2212 x 1659 pixels:
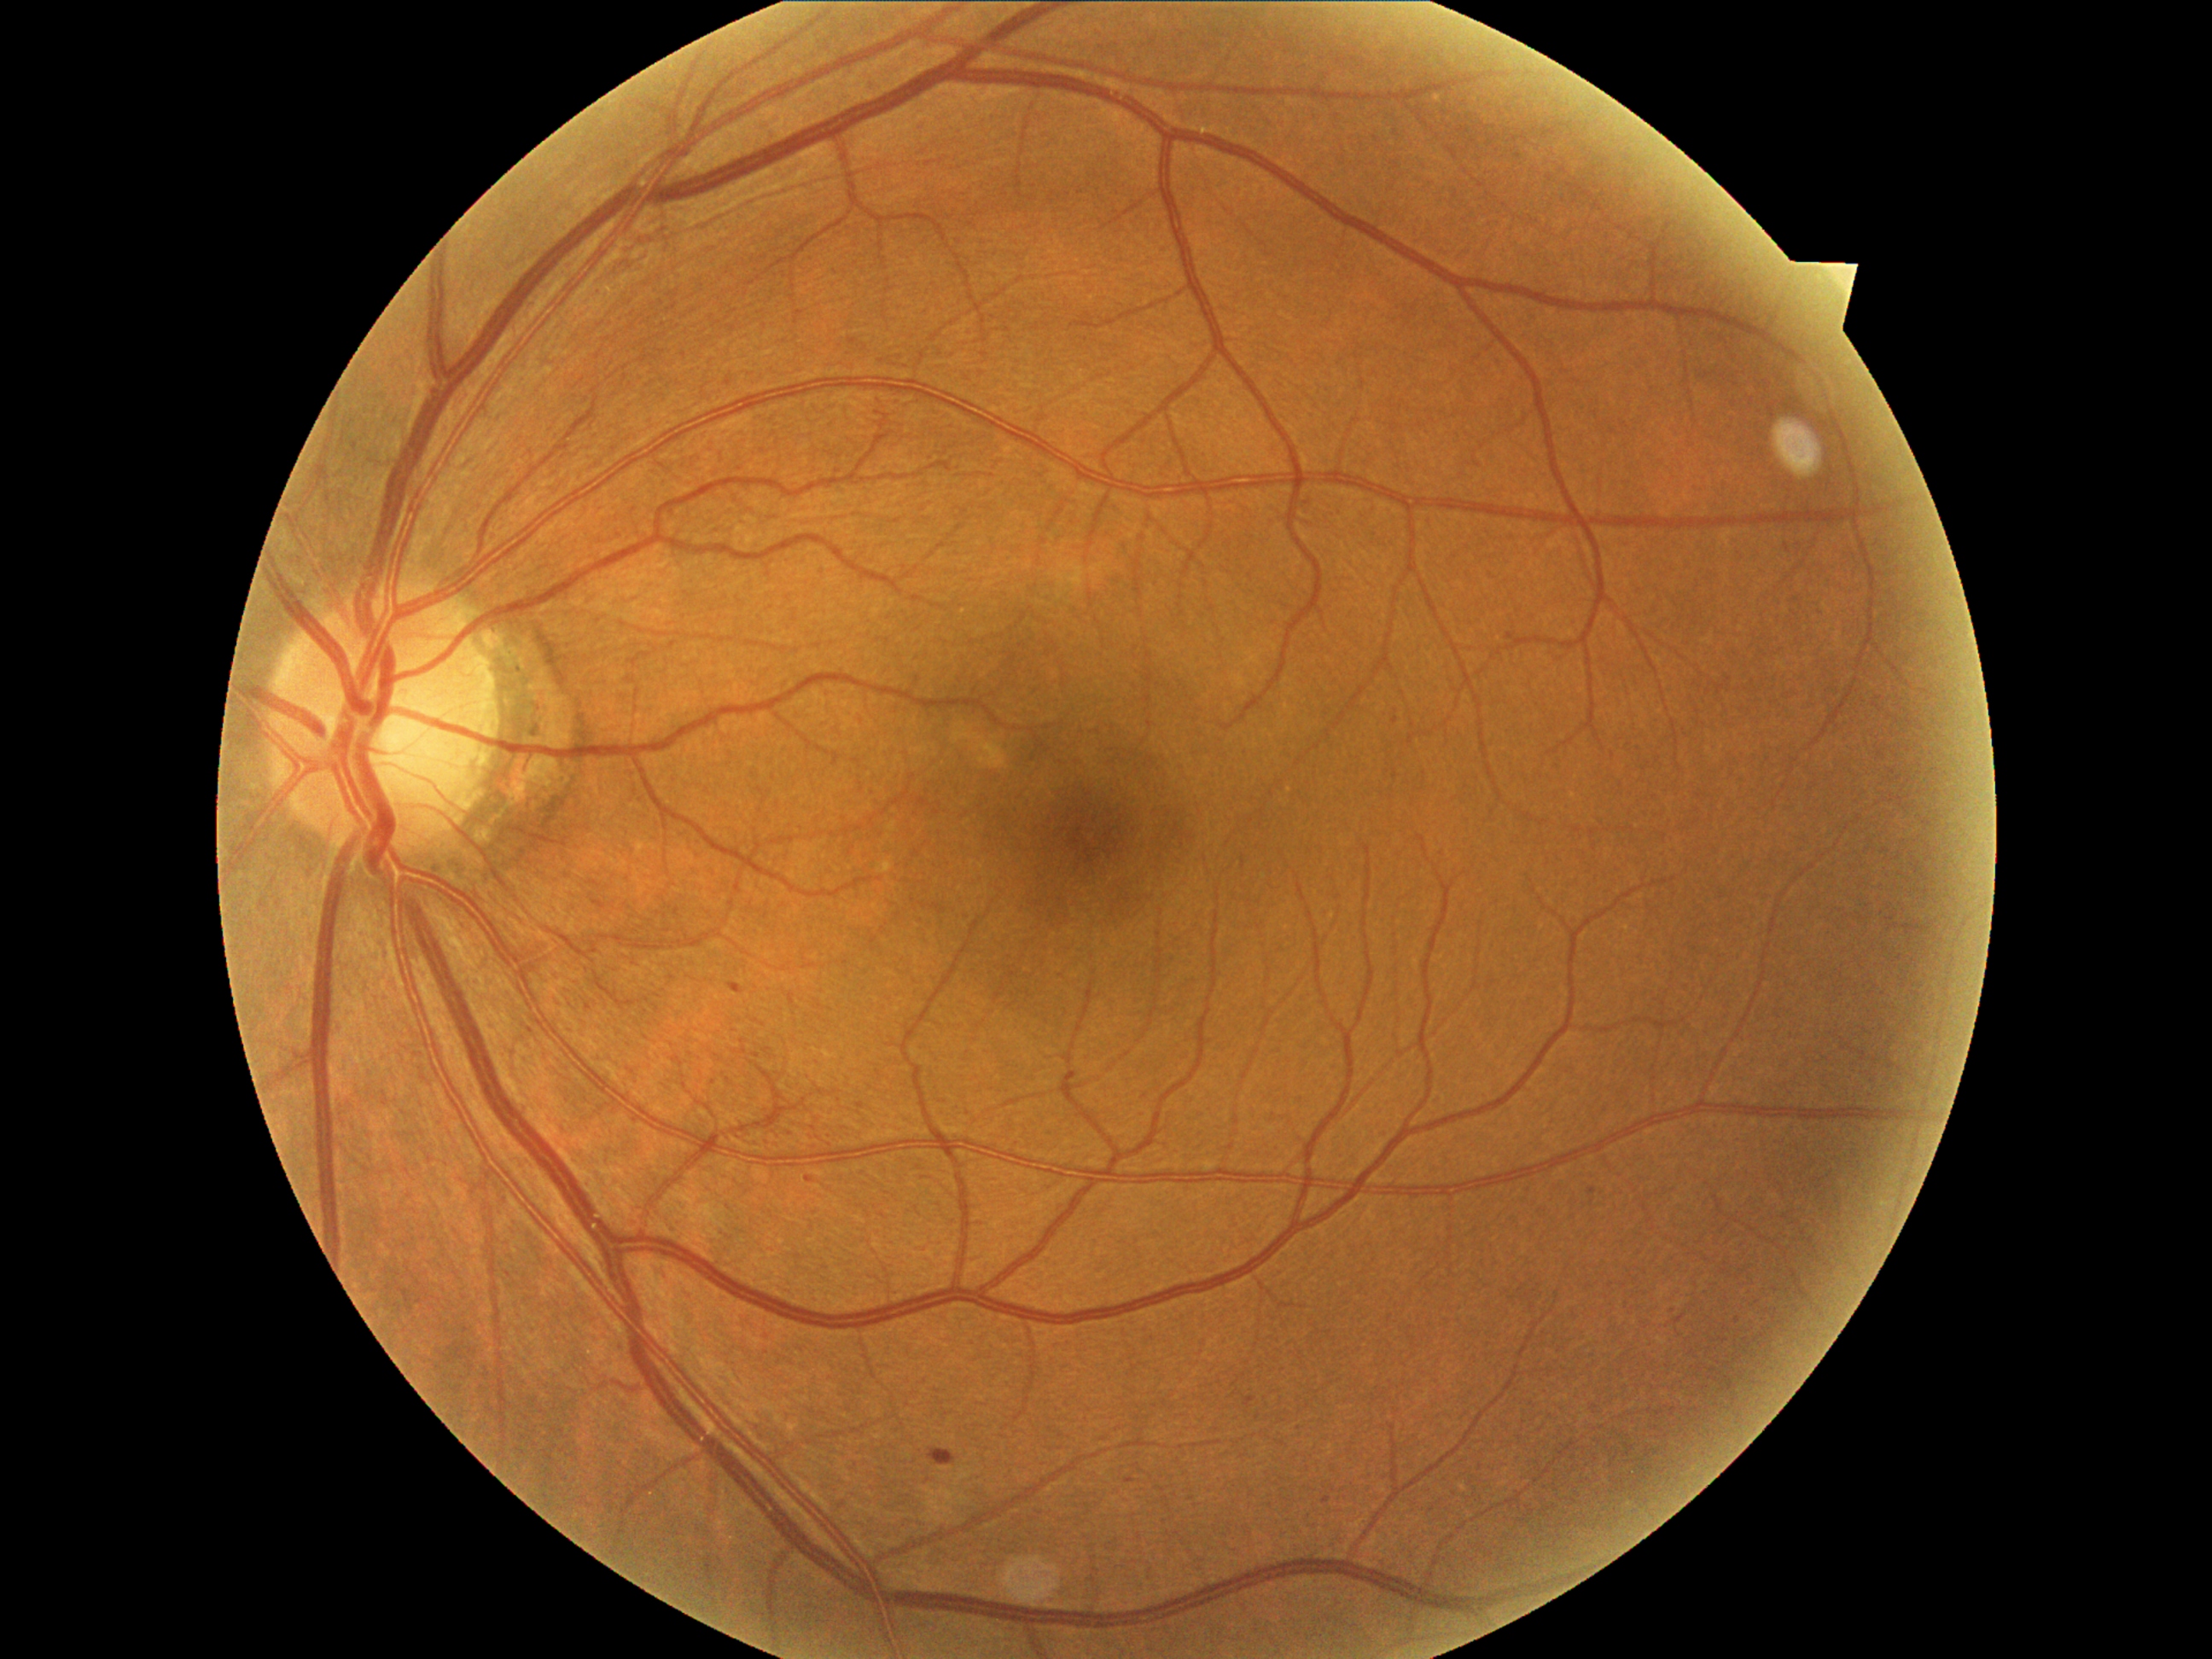
Diabetic retinopathy (DR) is 1; non-proliferative diabetic retinopathy. Microaneurysms (MAs) identified at rect(928, 1448, 957, 1467) | rect(1506, 632, 1528, 643) | rect(730, 982, 745, 994) | rect(1588, 1189, 1597, 1197) | rect(1126, 1479, 1136, 1484) | rect(806, 1175, 815, 1184) | rect(1245, 1397, 1257, 1407). Small MAs approximately at Point(1396, 721) | Point(1327, 1499) | Point(728, 382) | Point(1738, 1320) | Point(861, 1106). No soft exudates (SEs) identified. No hard exudates (EXs) identified. No hemorrhages (HEs) identified.